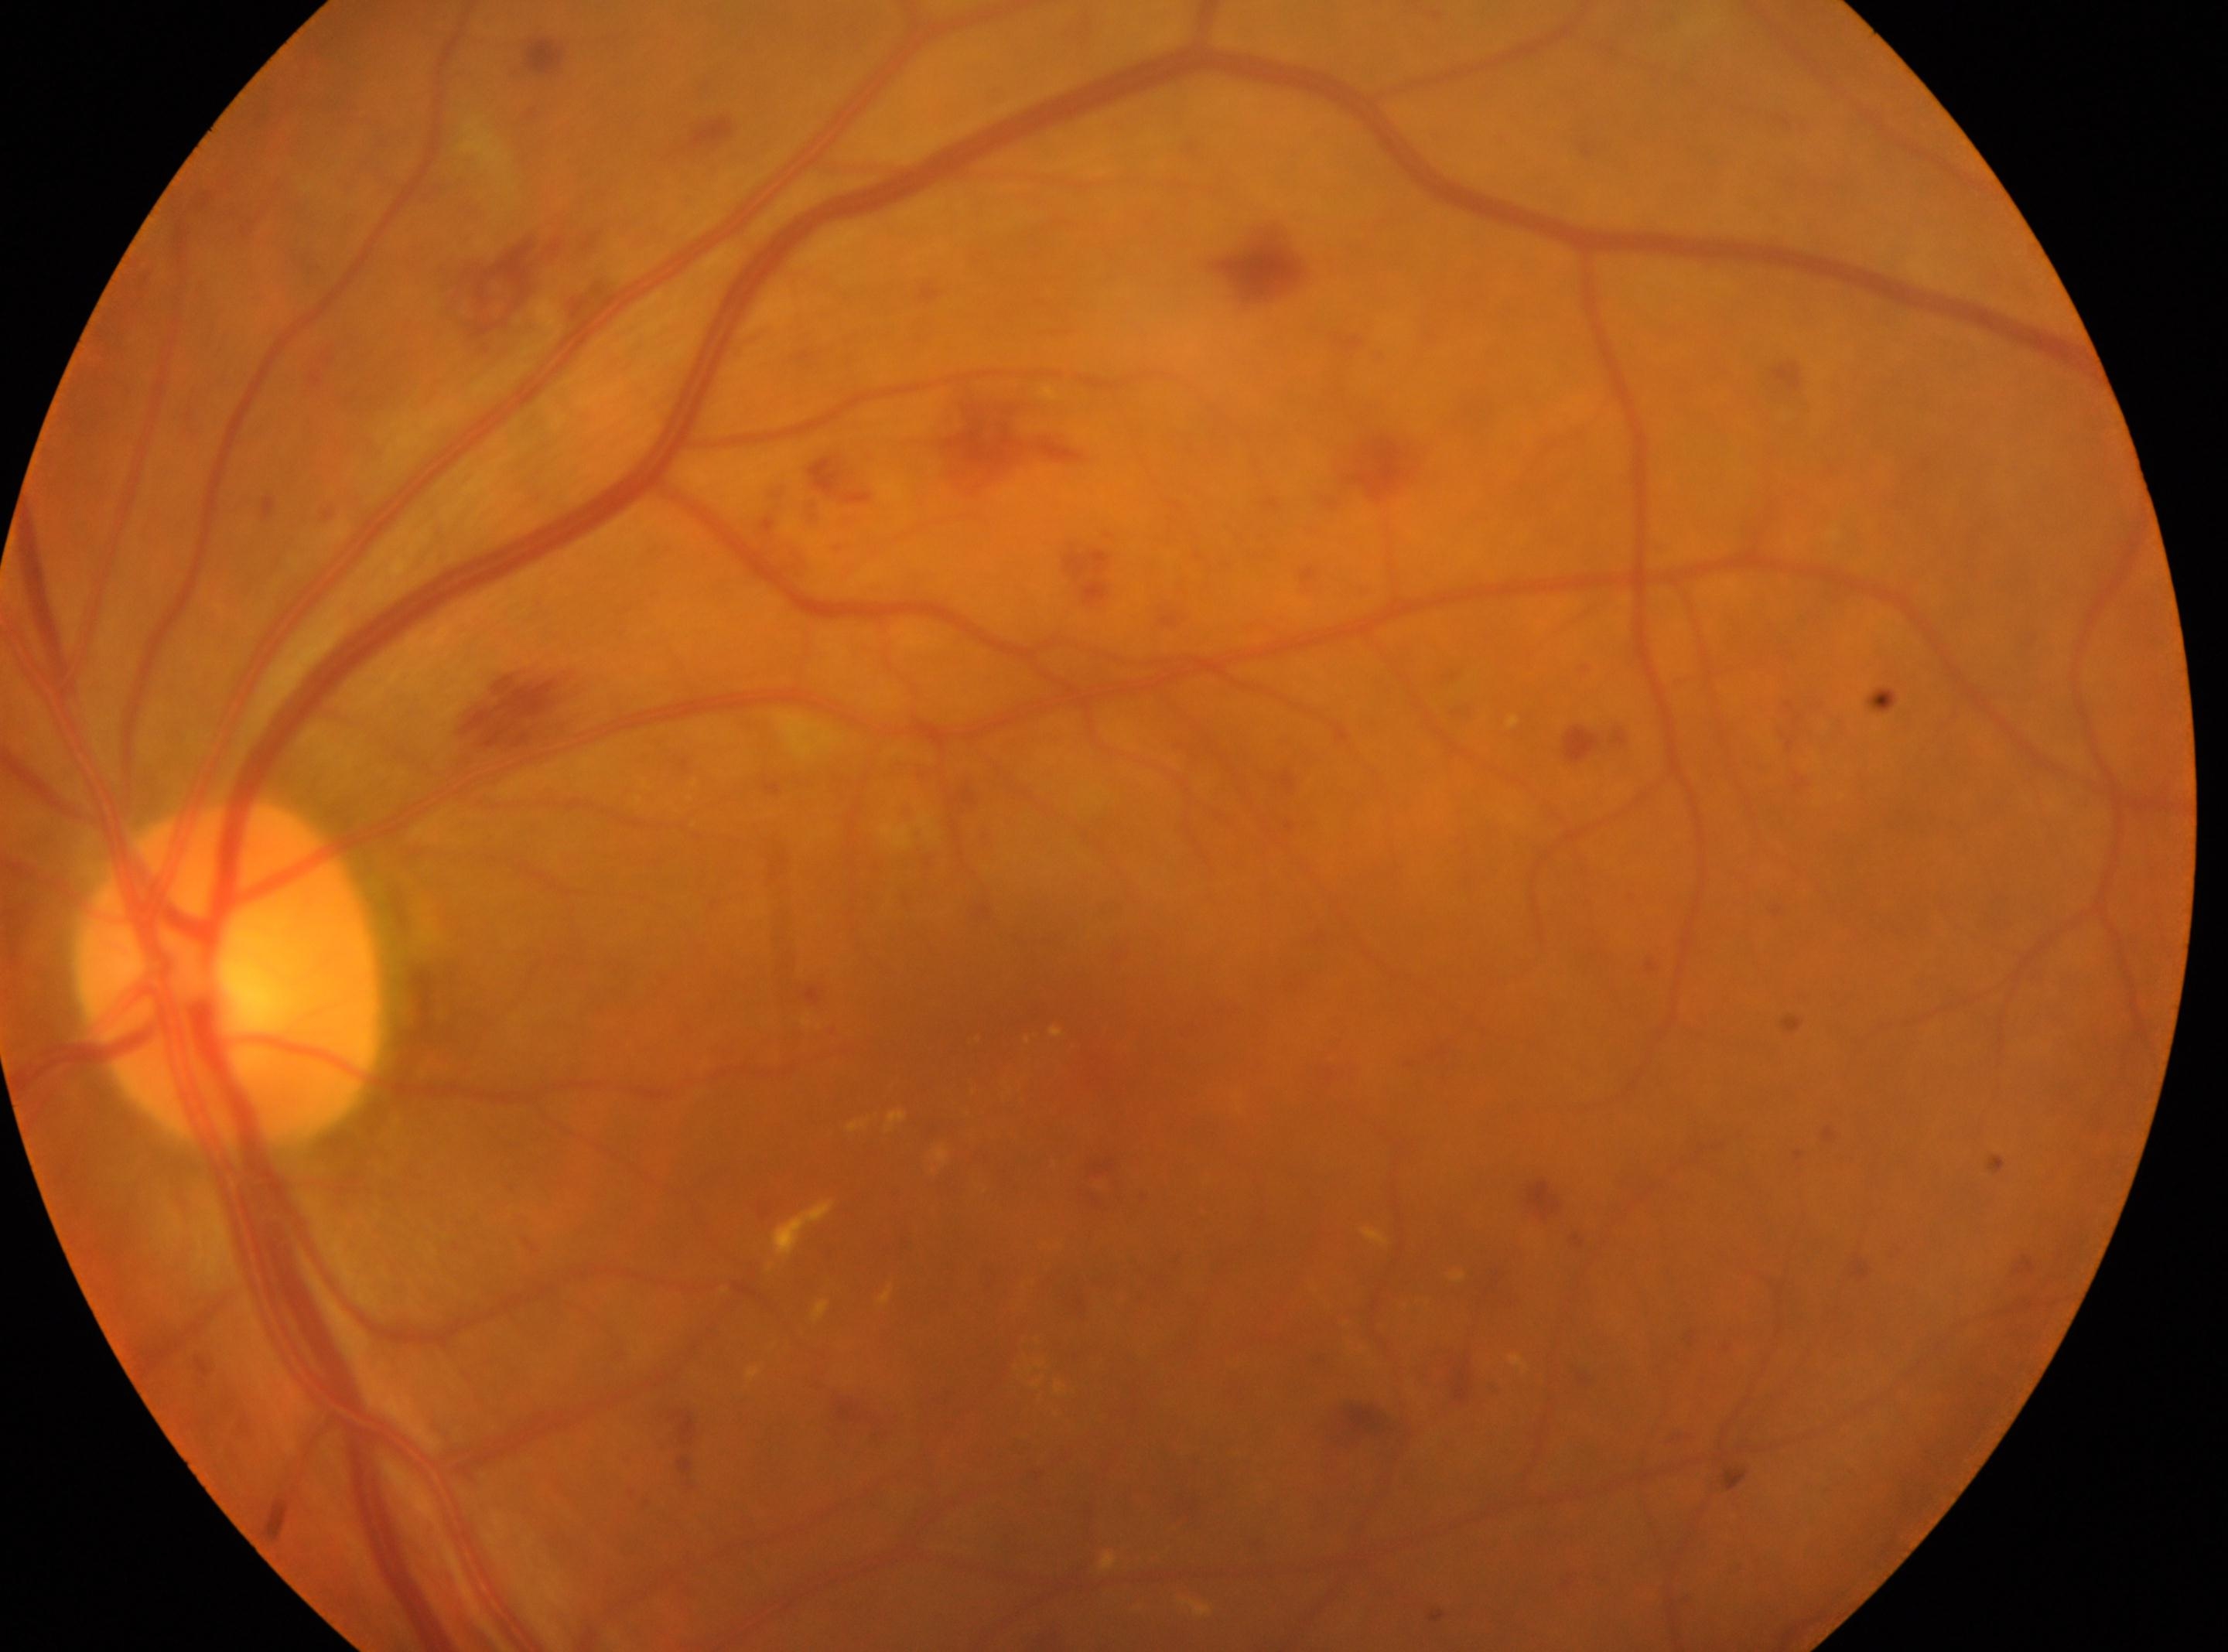

DR stage: 2/4.
Optic disc located at (228,975).
This is the left eye.
The fovea is at (1082,1092).
DR class: non-proliferative diabetic retinopathy.